NIDEK AFC-230 fundus camera · nonmydriatic fundus photograph:
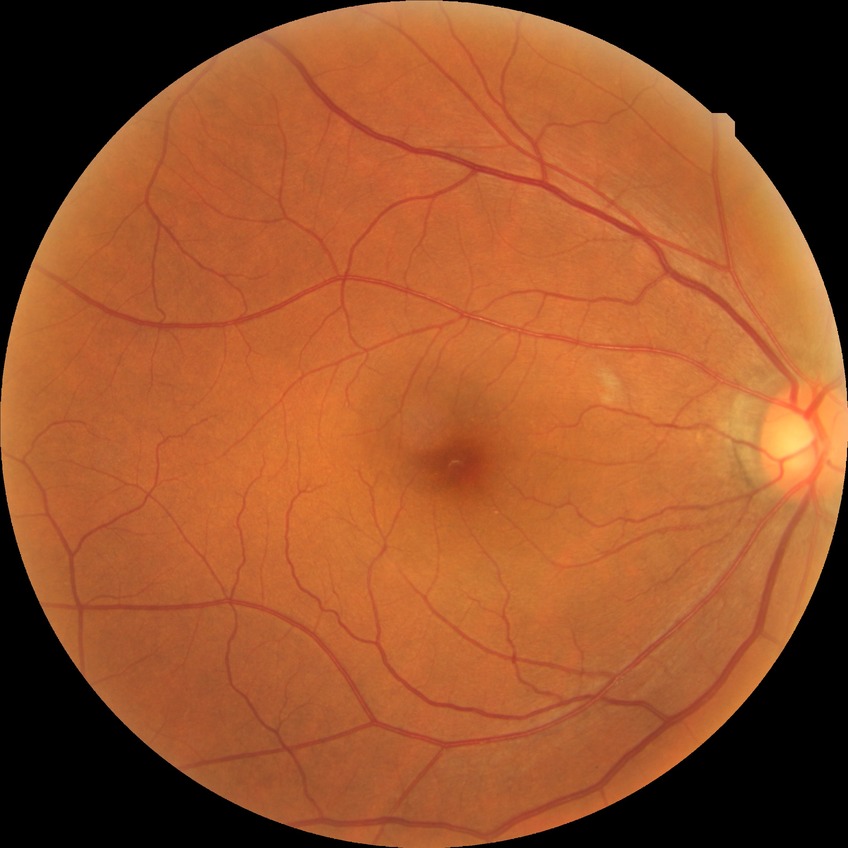 diabetic retinopathy (DR)@no diabetic retinopathy (NDR).